Retinal fundus photograph, 45 degree fundus photograph
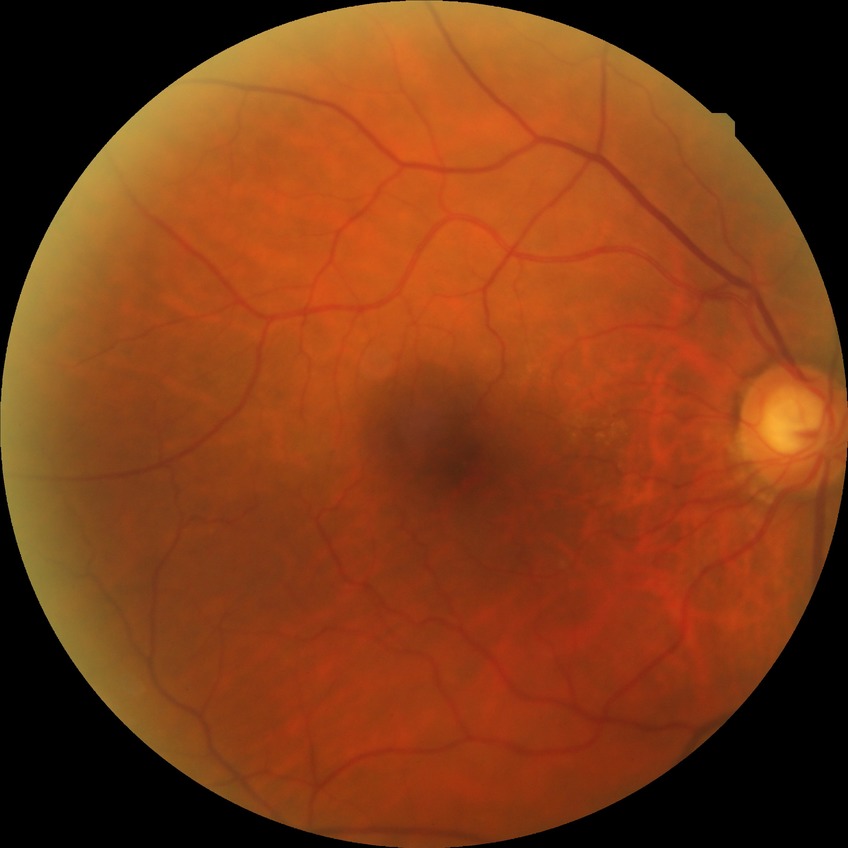 diabetic retinopathy (DR)@NDR (no diabetic retinopathy).